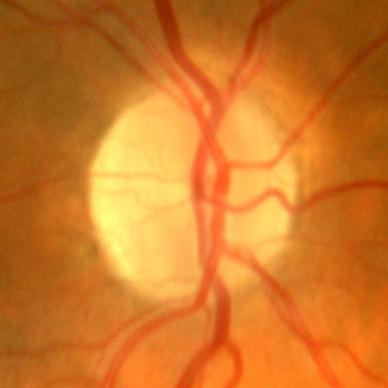
Q: Does this eye have glaucoma?
A: No evidence of glaucoma.